Modified Davis classification.
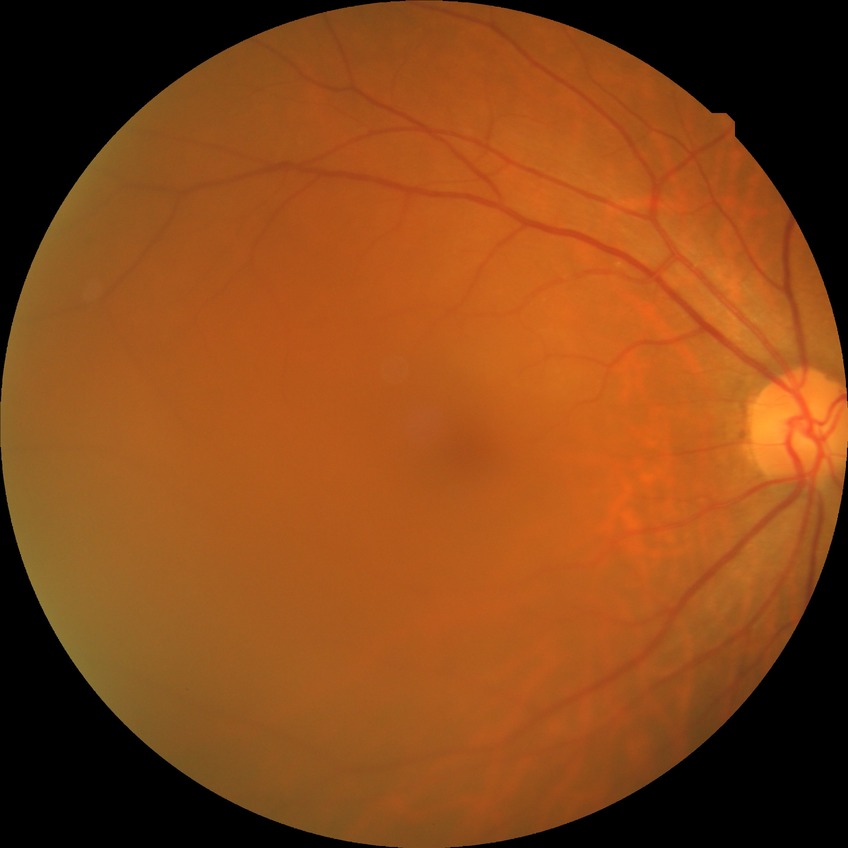 Annotations:
- diabetic retinopathy stage: no diabetic retinopathy